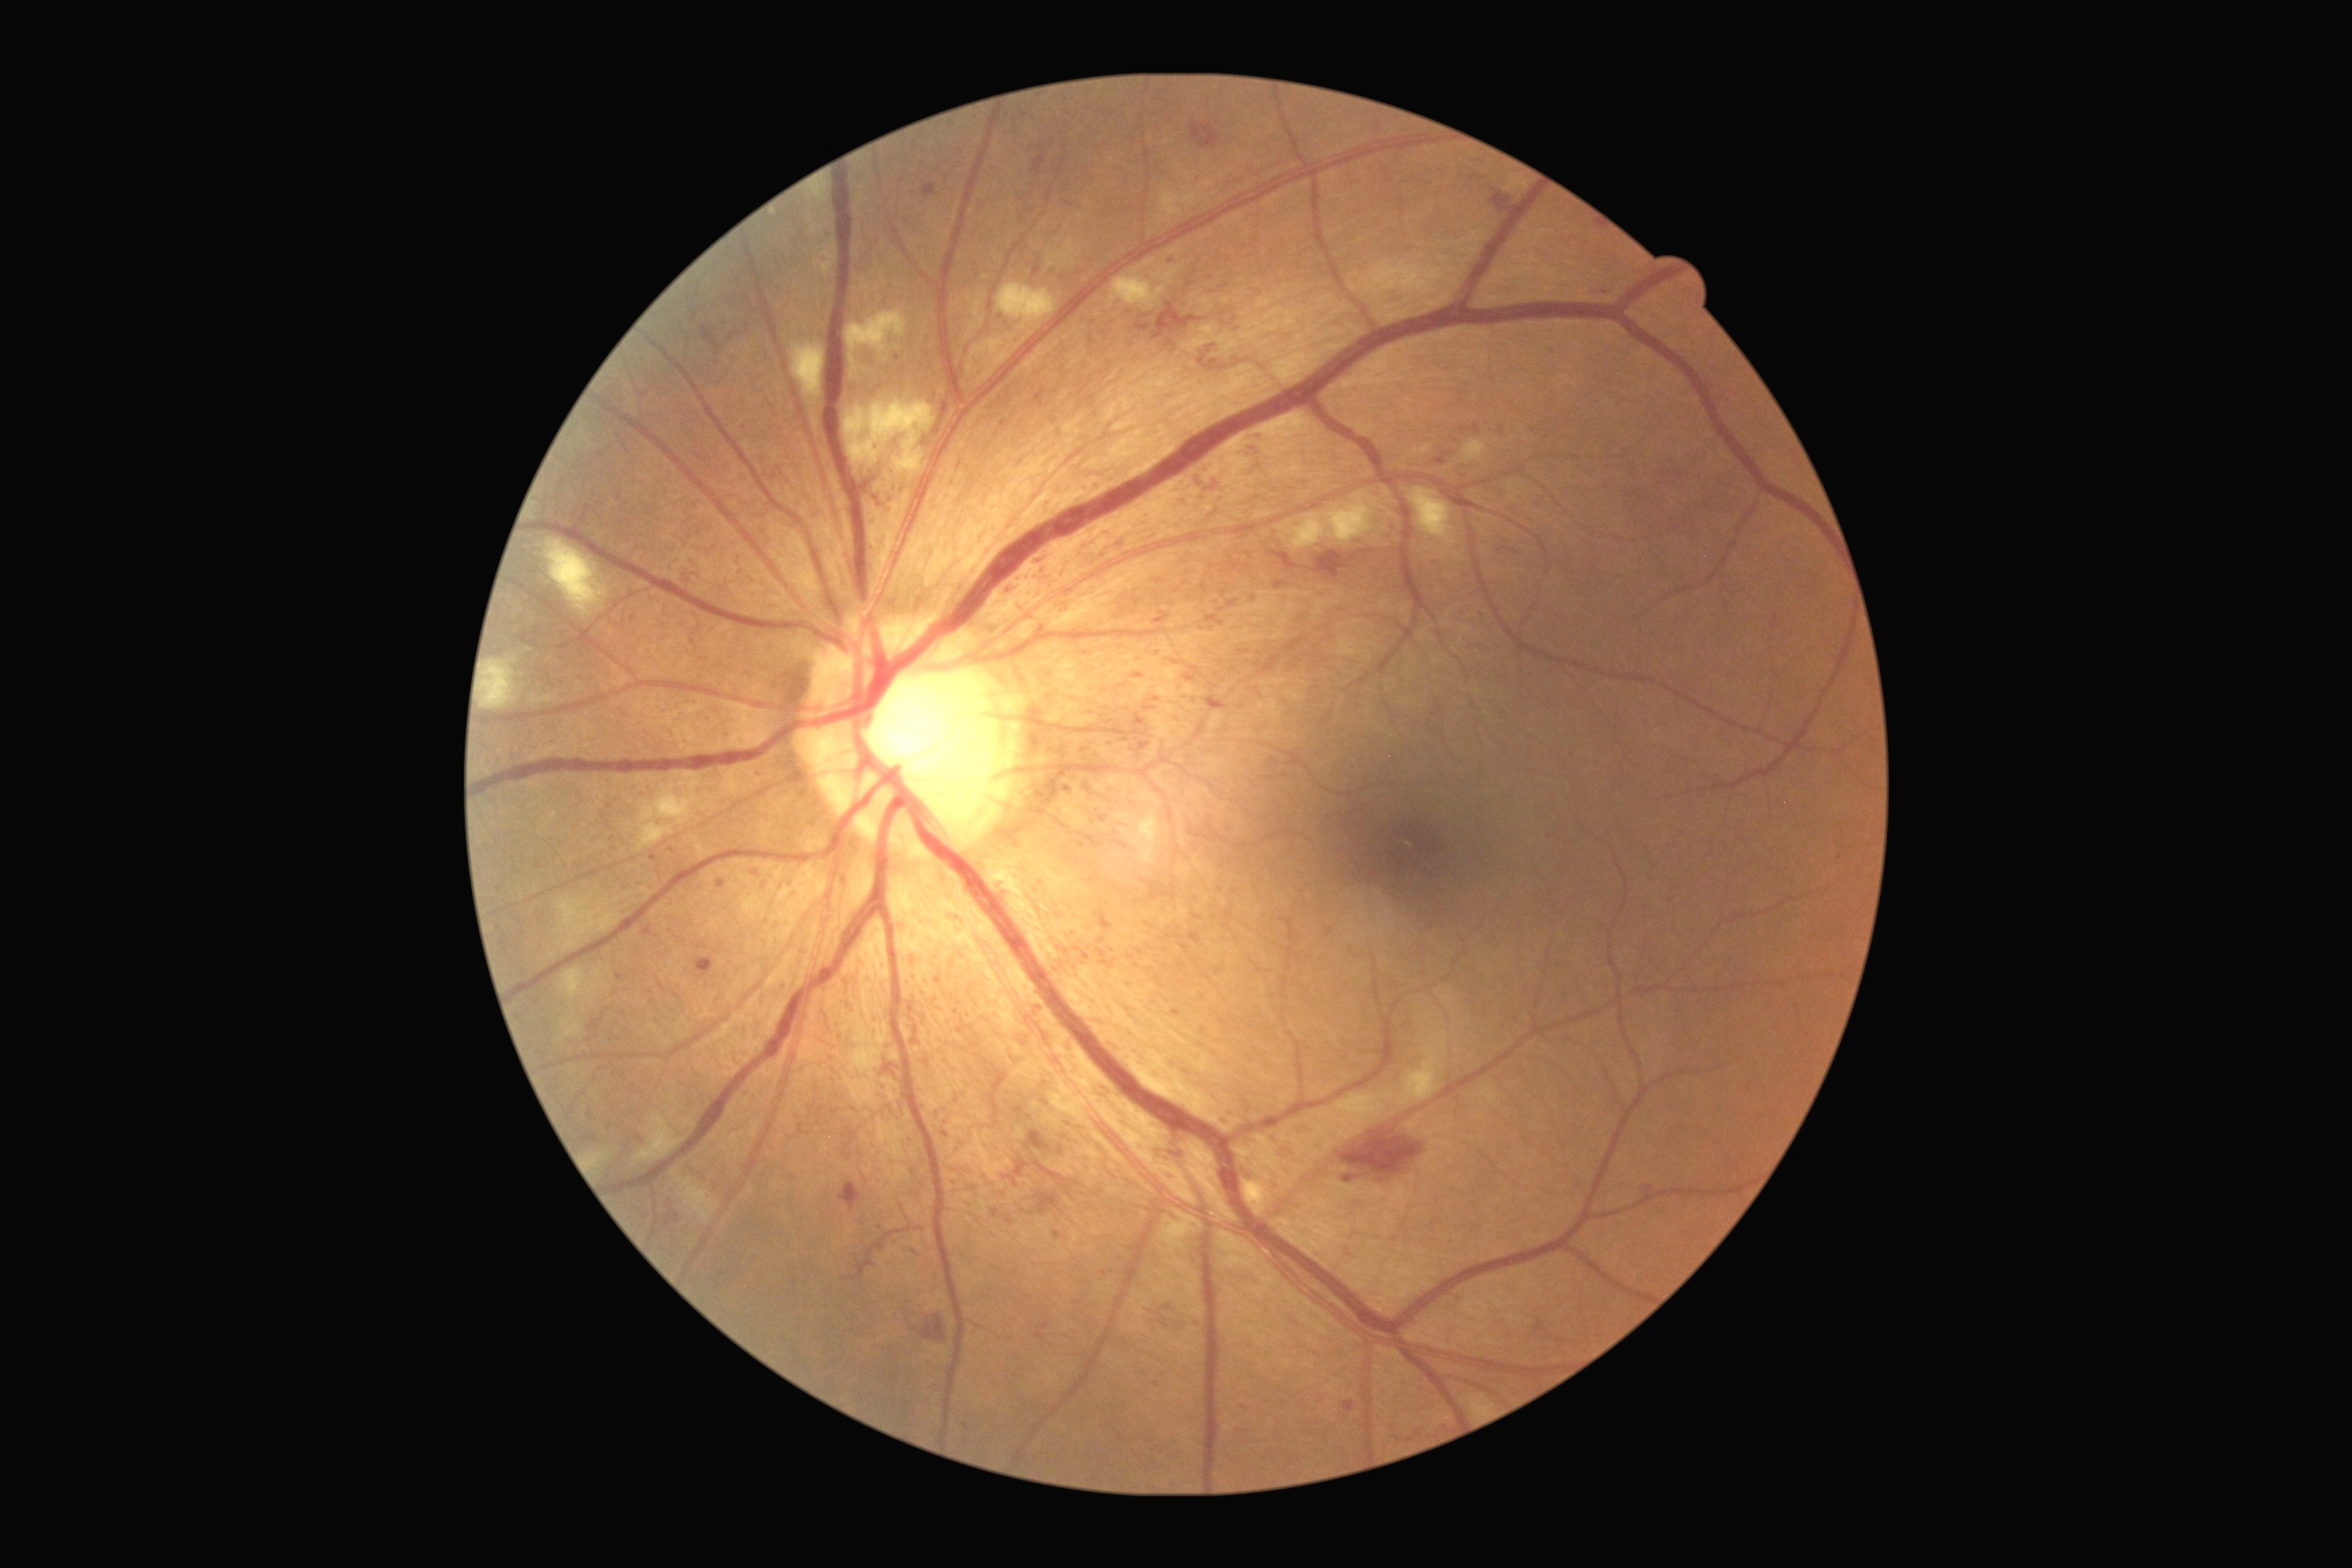

Retinopathy is 3/4
Lesions identified (partial list):
microaneurysms (partial): x1=1184, y1=674, x2=1195, y2=681, x1=643, y1=926, x2=652, y2=936, x1=876, y1=1246, x2=885, y2=1253, x1=1444, y1=580, x2=1451, y2=589, x1=1190, y1=932, x2=1202, y2=945, x1=1166, y1=340, x2=1175, y2=346, x1=1770, y1=616, x2=1779, y2=629, x1=936, y1=977, x2=943, y2=985, x1=1191, y1=669, x2=1199, y2=674, x1=665, y1=1213, x2=680, y2=1228
Small microaneurysms approximately at x=1208, y=827, x=881, y=387, x=1204, y=997, x=896, y=359, x=1031, y=210, x=790, y=1139, x=1149, y=924